Captured with the Phoenix ICON (100° field of view); wide-field fundus photograph from neonatal ROP screening: 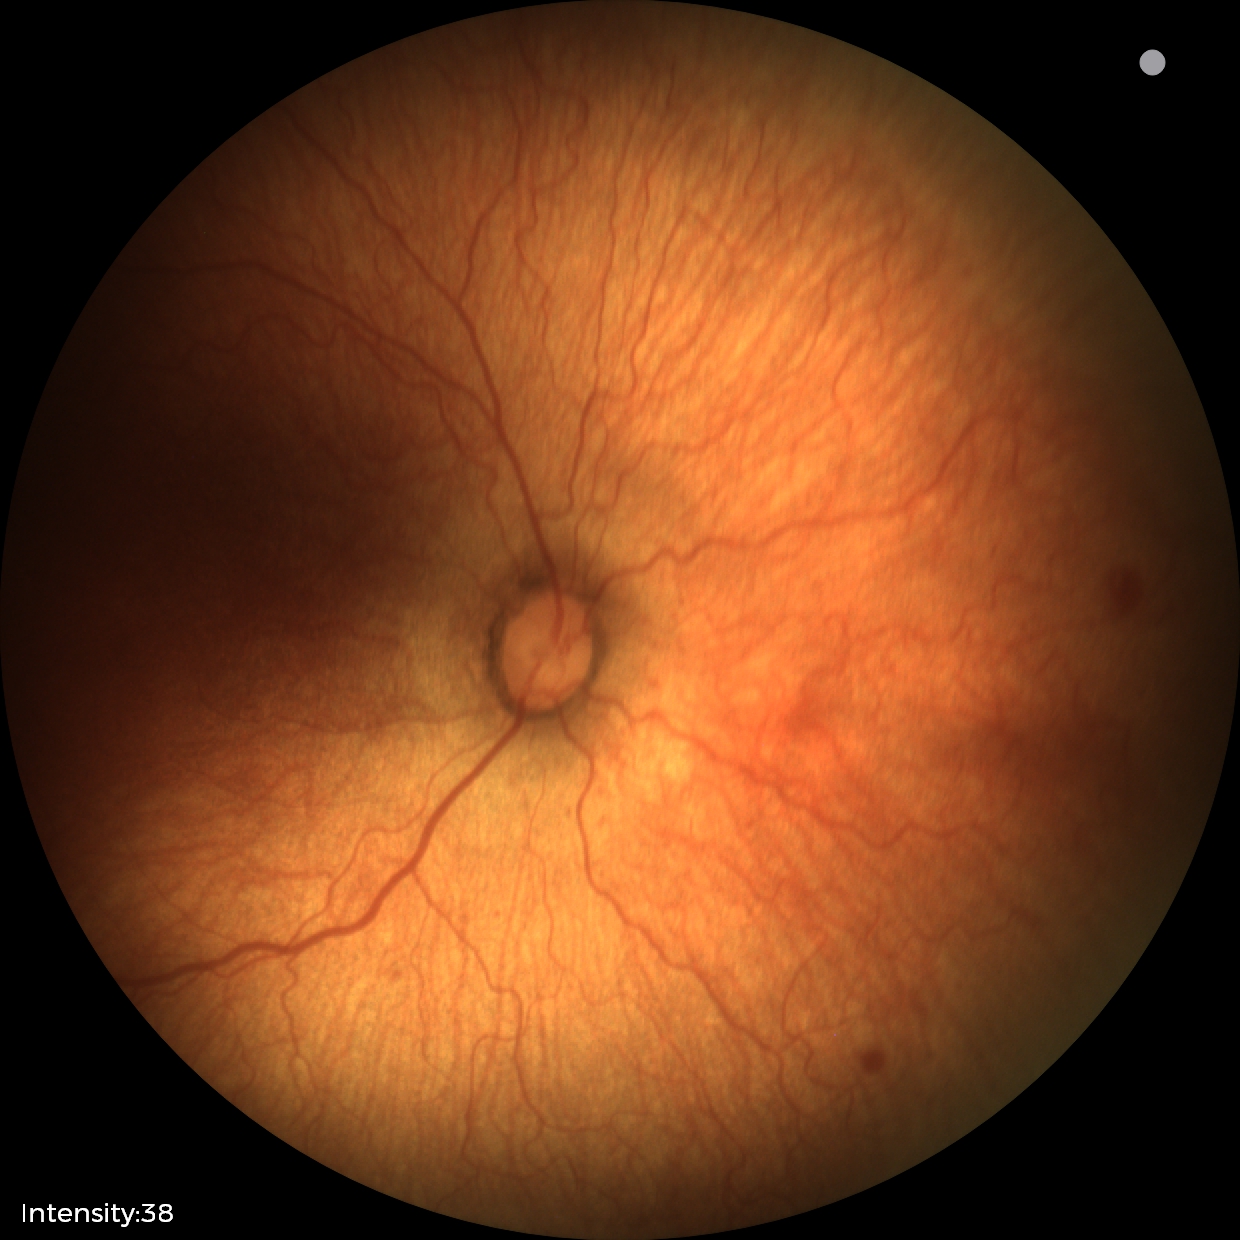

Diagnosis = ROP stage 1.